Without pupil dilation:
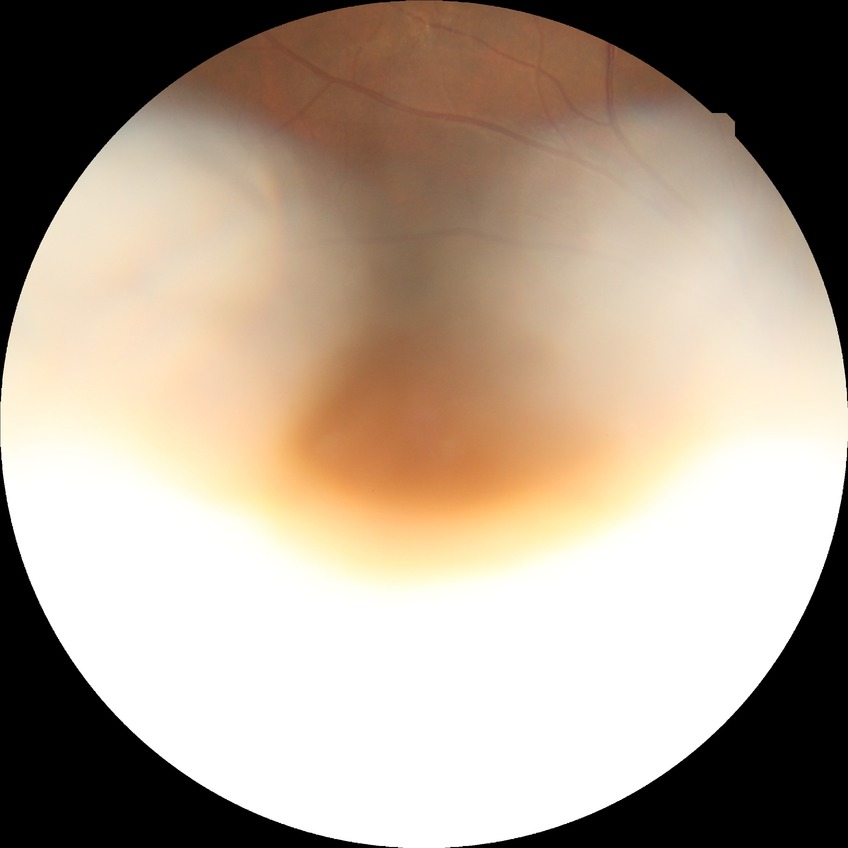 {
  "davis_grade": "NDR"
}